Nonmydriatic fundus photograph — 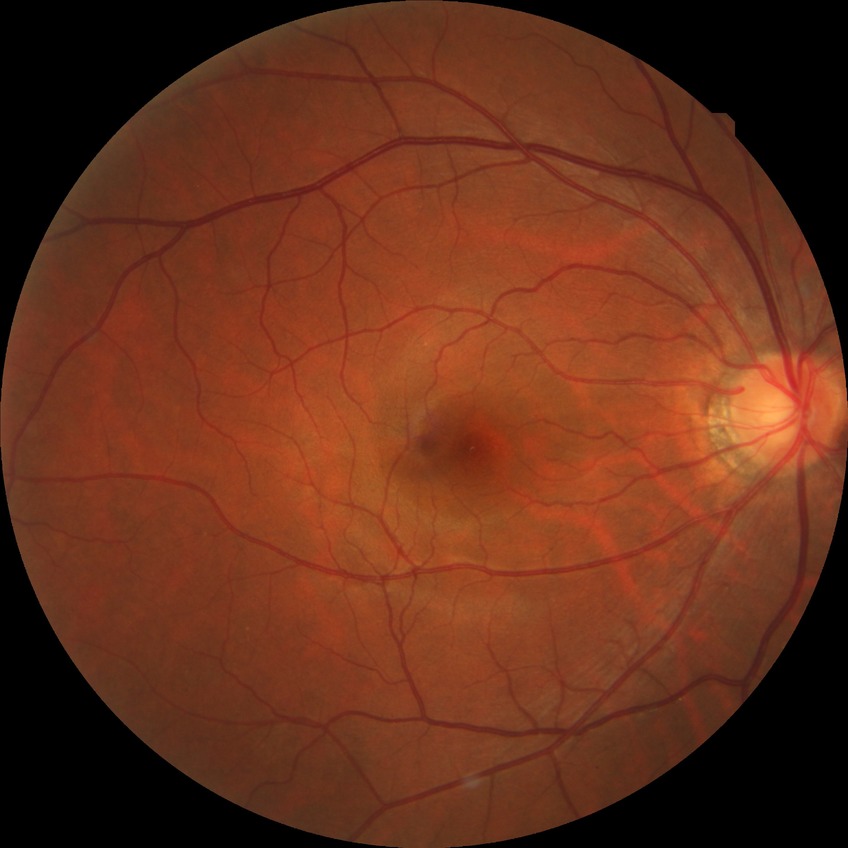

Davis DR grade: NDR, DR impression: no apparent DR.